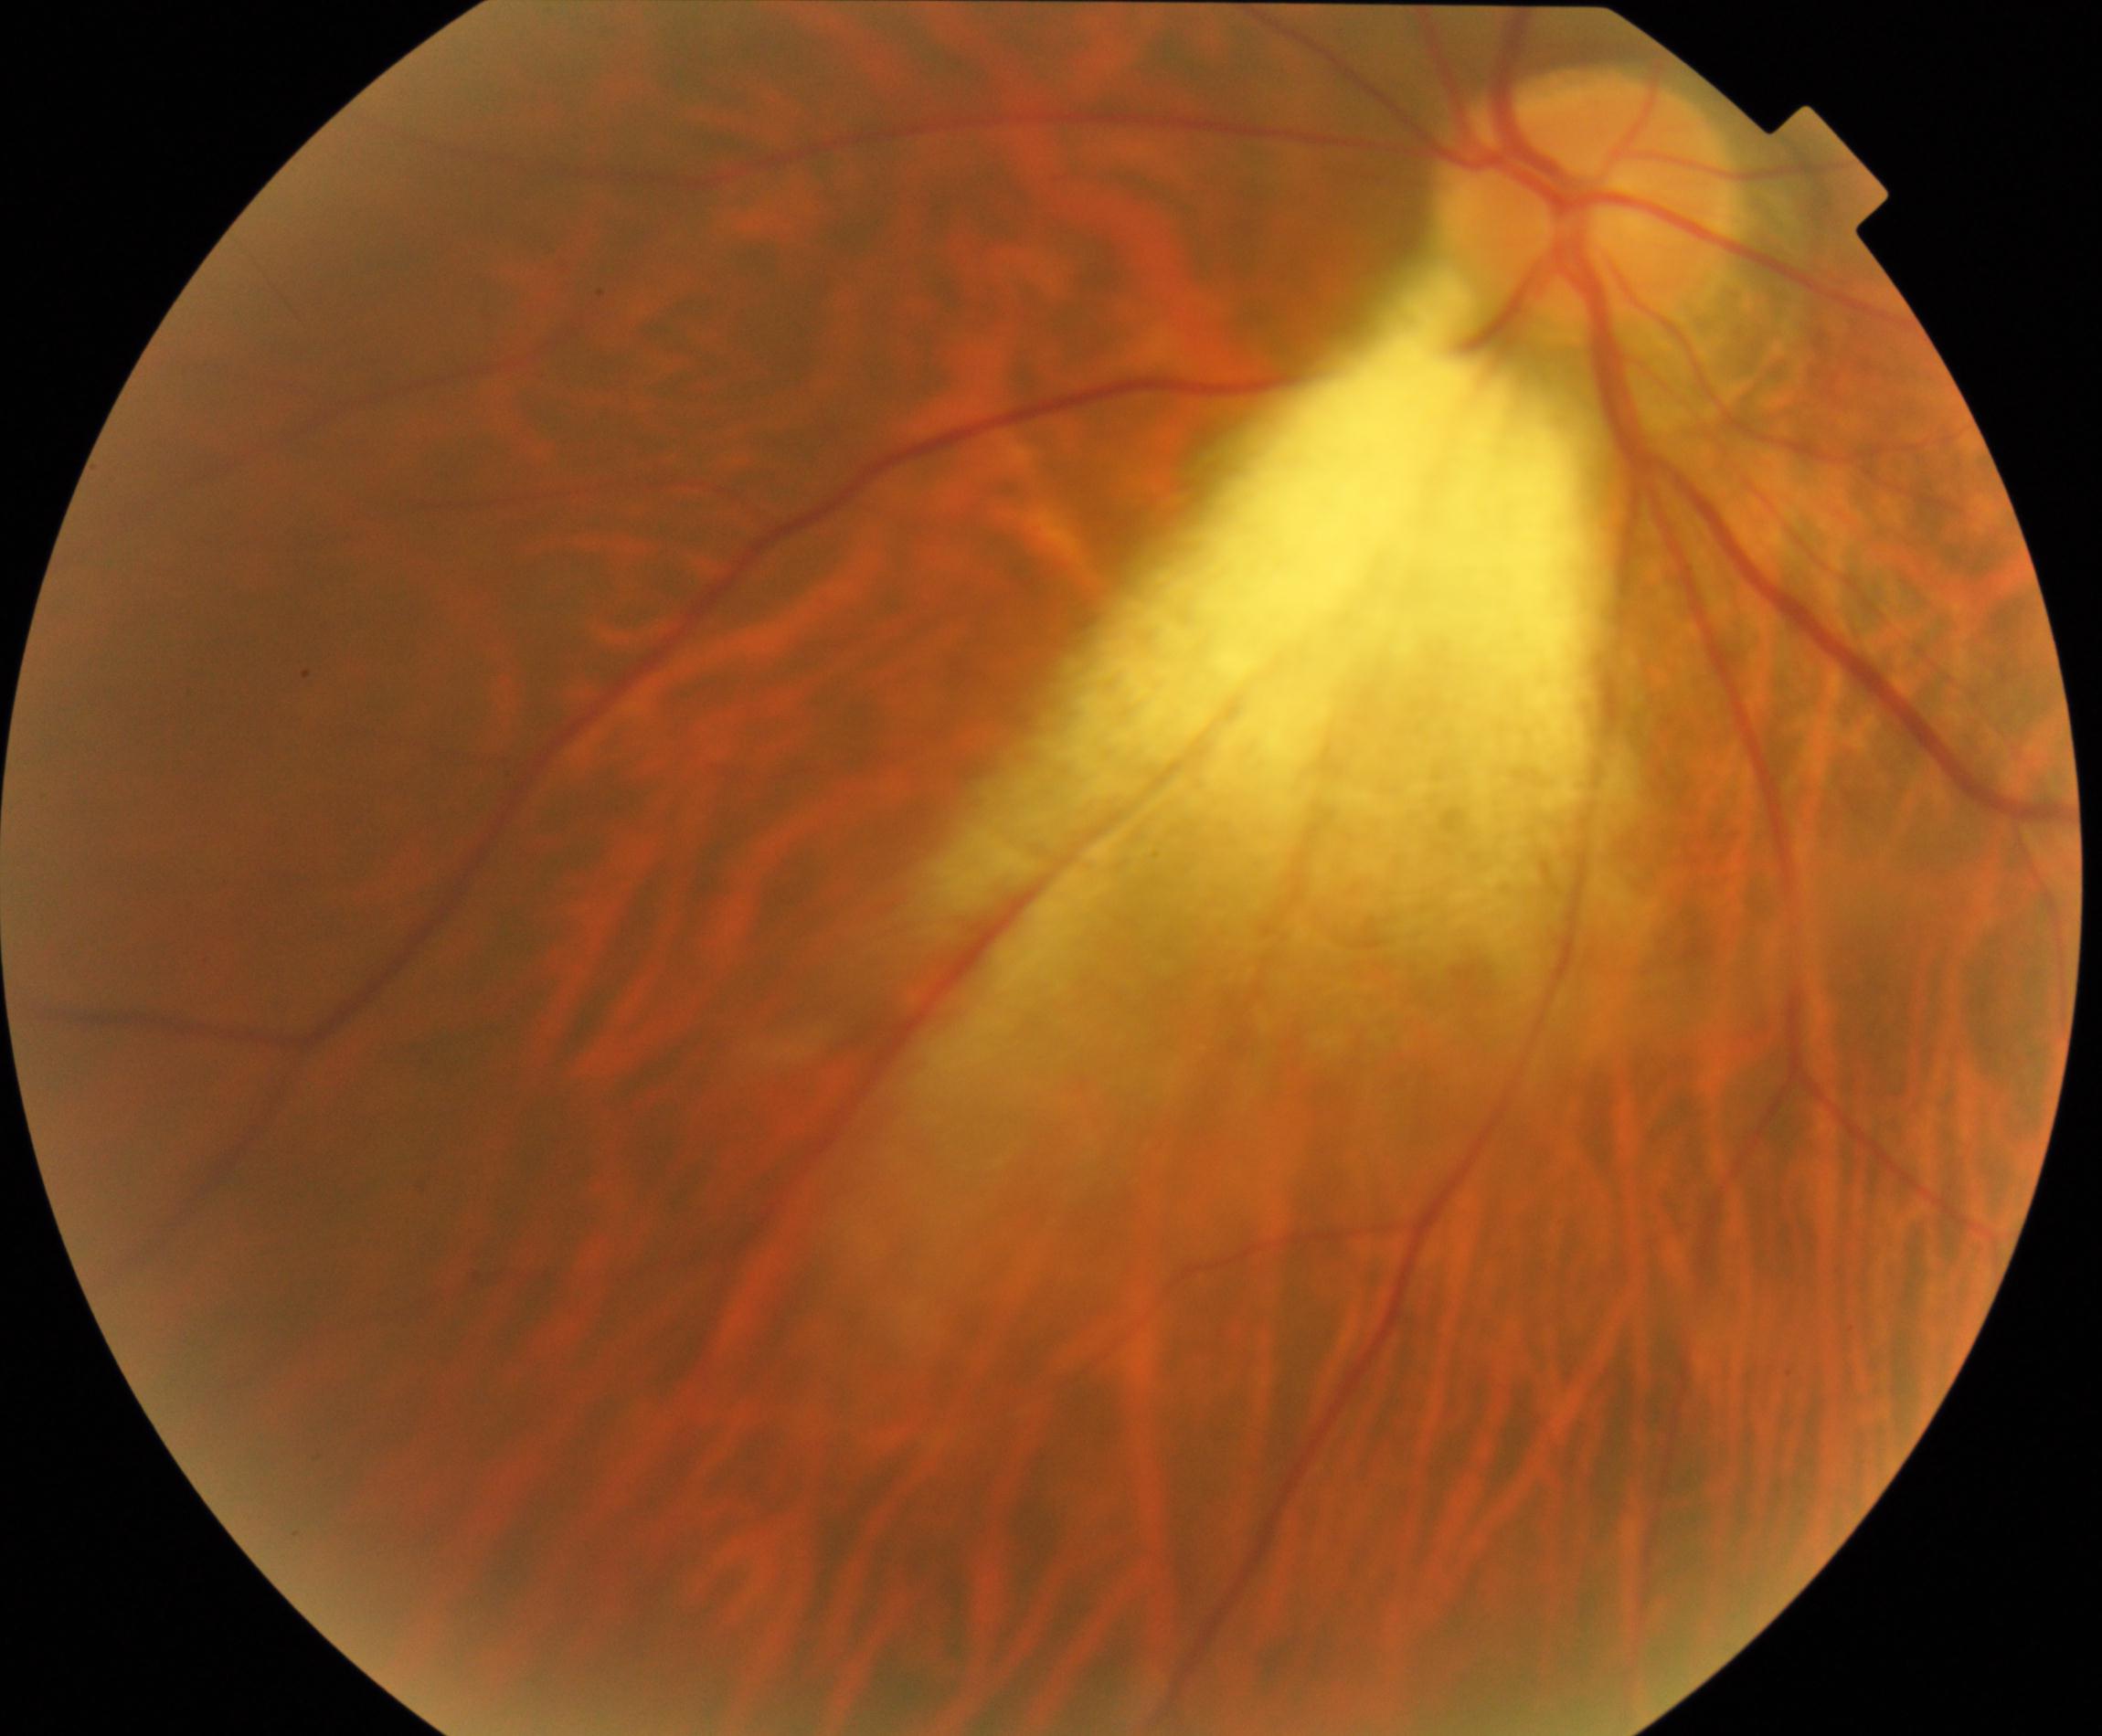

Impression: myelinated nerve fibers.